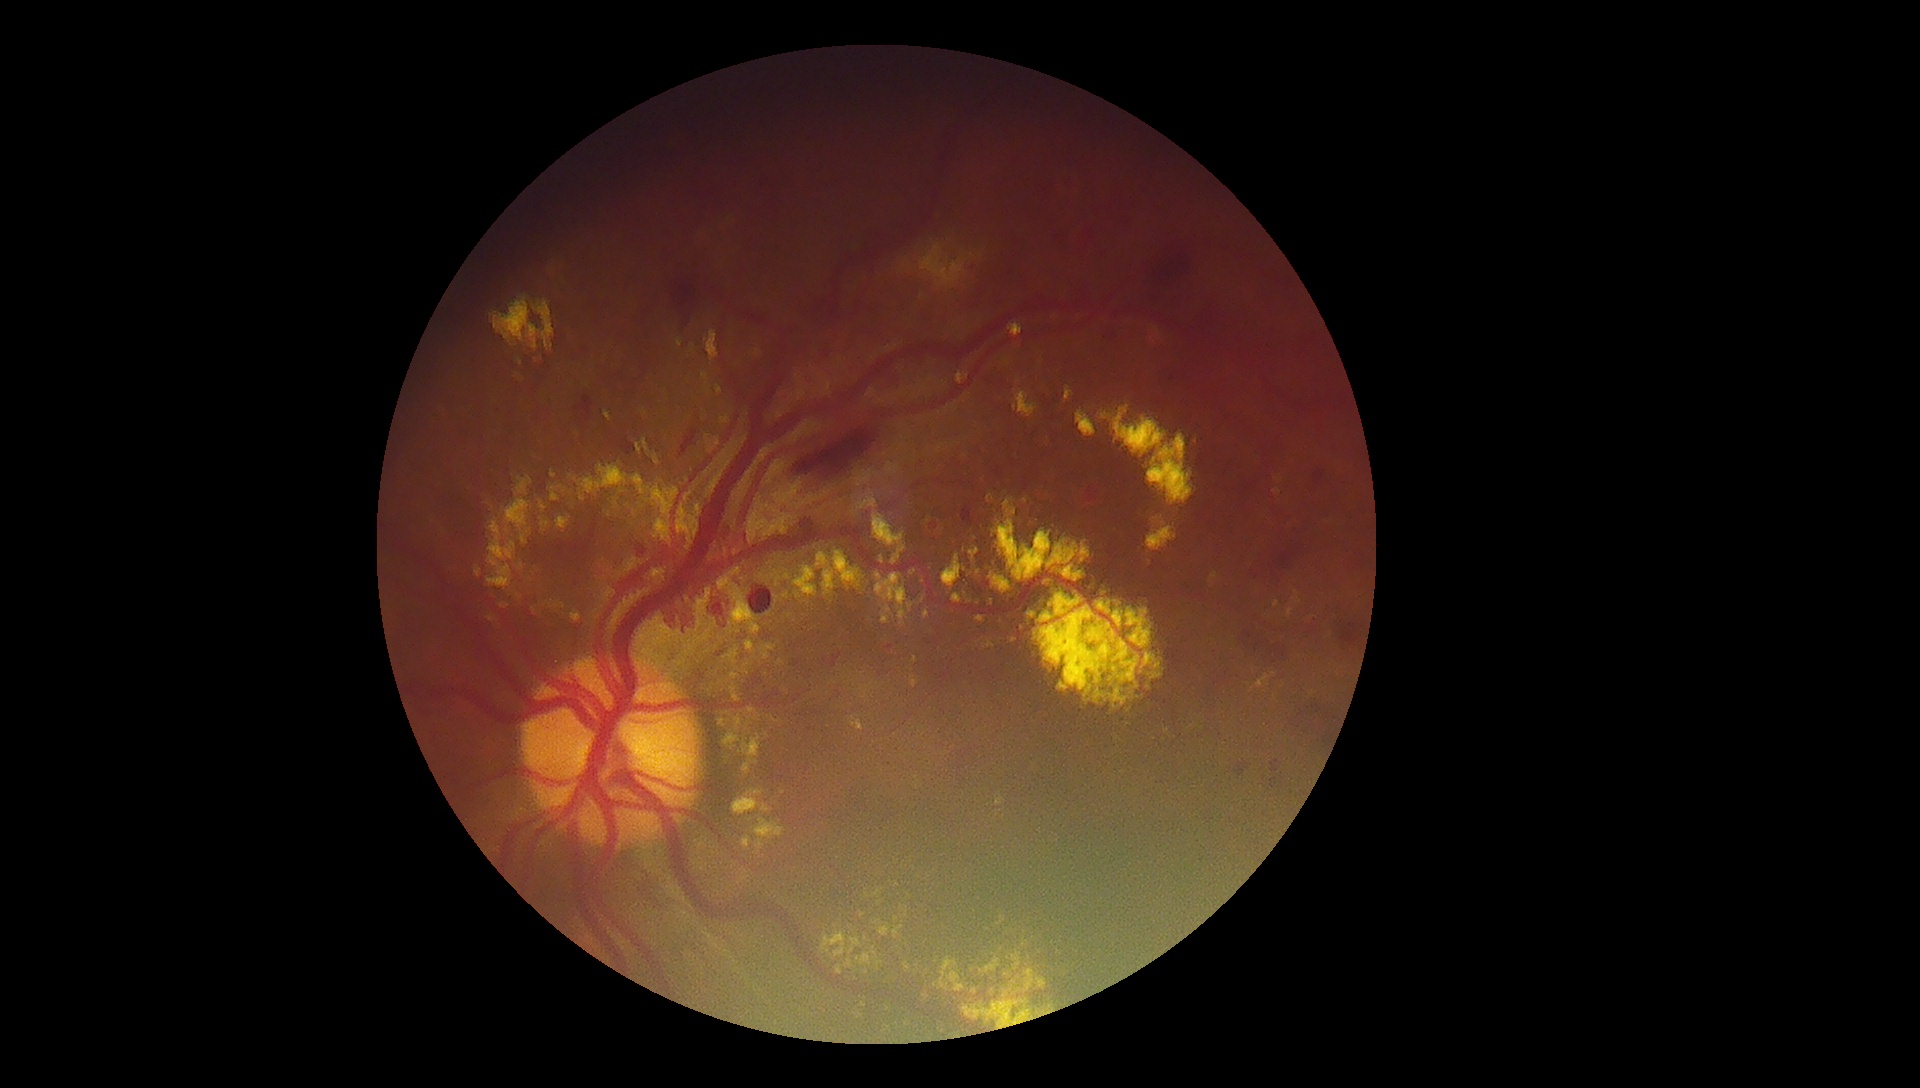 {"partial":true,"dr_grade":4,"lesions":{"ex":[[923,993,930,1001],[859,1002,867,1008],[487,519,517,591],[903,962,912,973],[1287,608,1294,618],[702,373,709,385],[794,566,817,597],[946,972,965,992],[760,645,776,660],[651,485,680,522],[544,601,566,610],[746,641,757,653]],"ex_small_approx":[[692,350],[750,734],[897,919],[877,922],[879,903],[608,515]]}}